45° field of view · 1932x1916px:
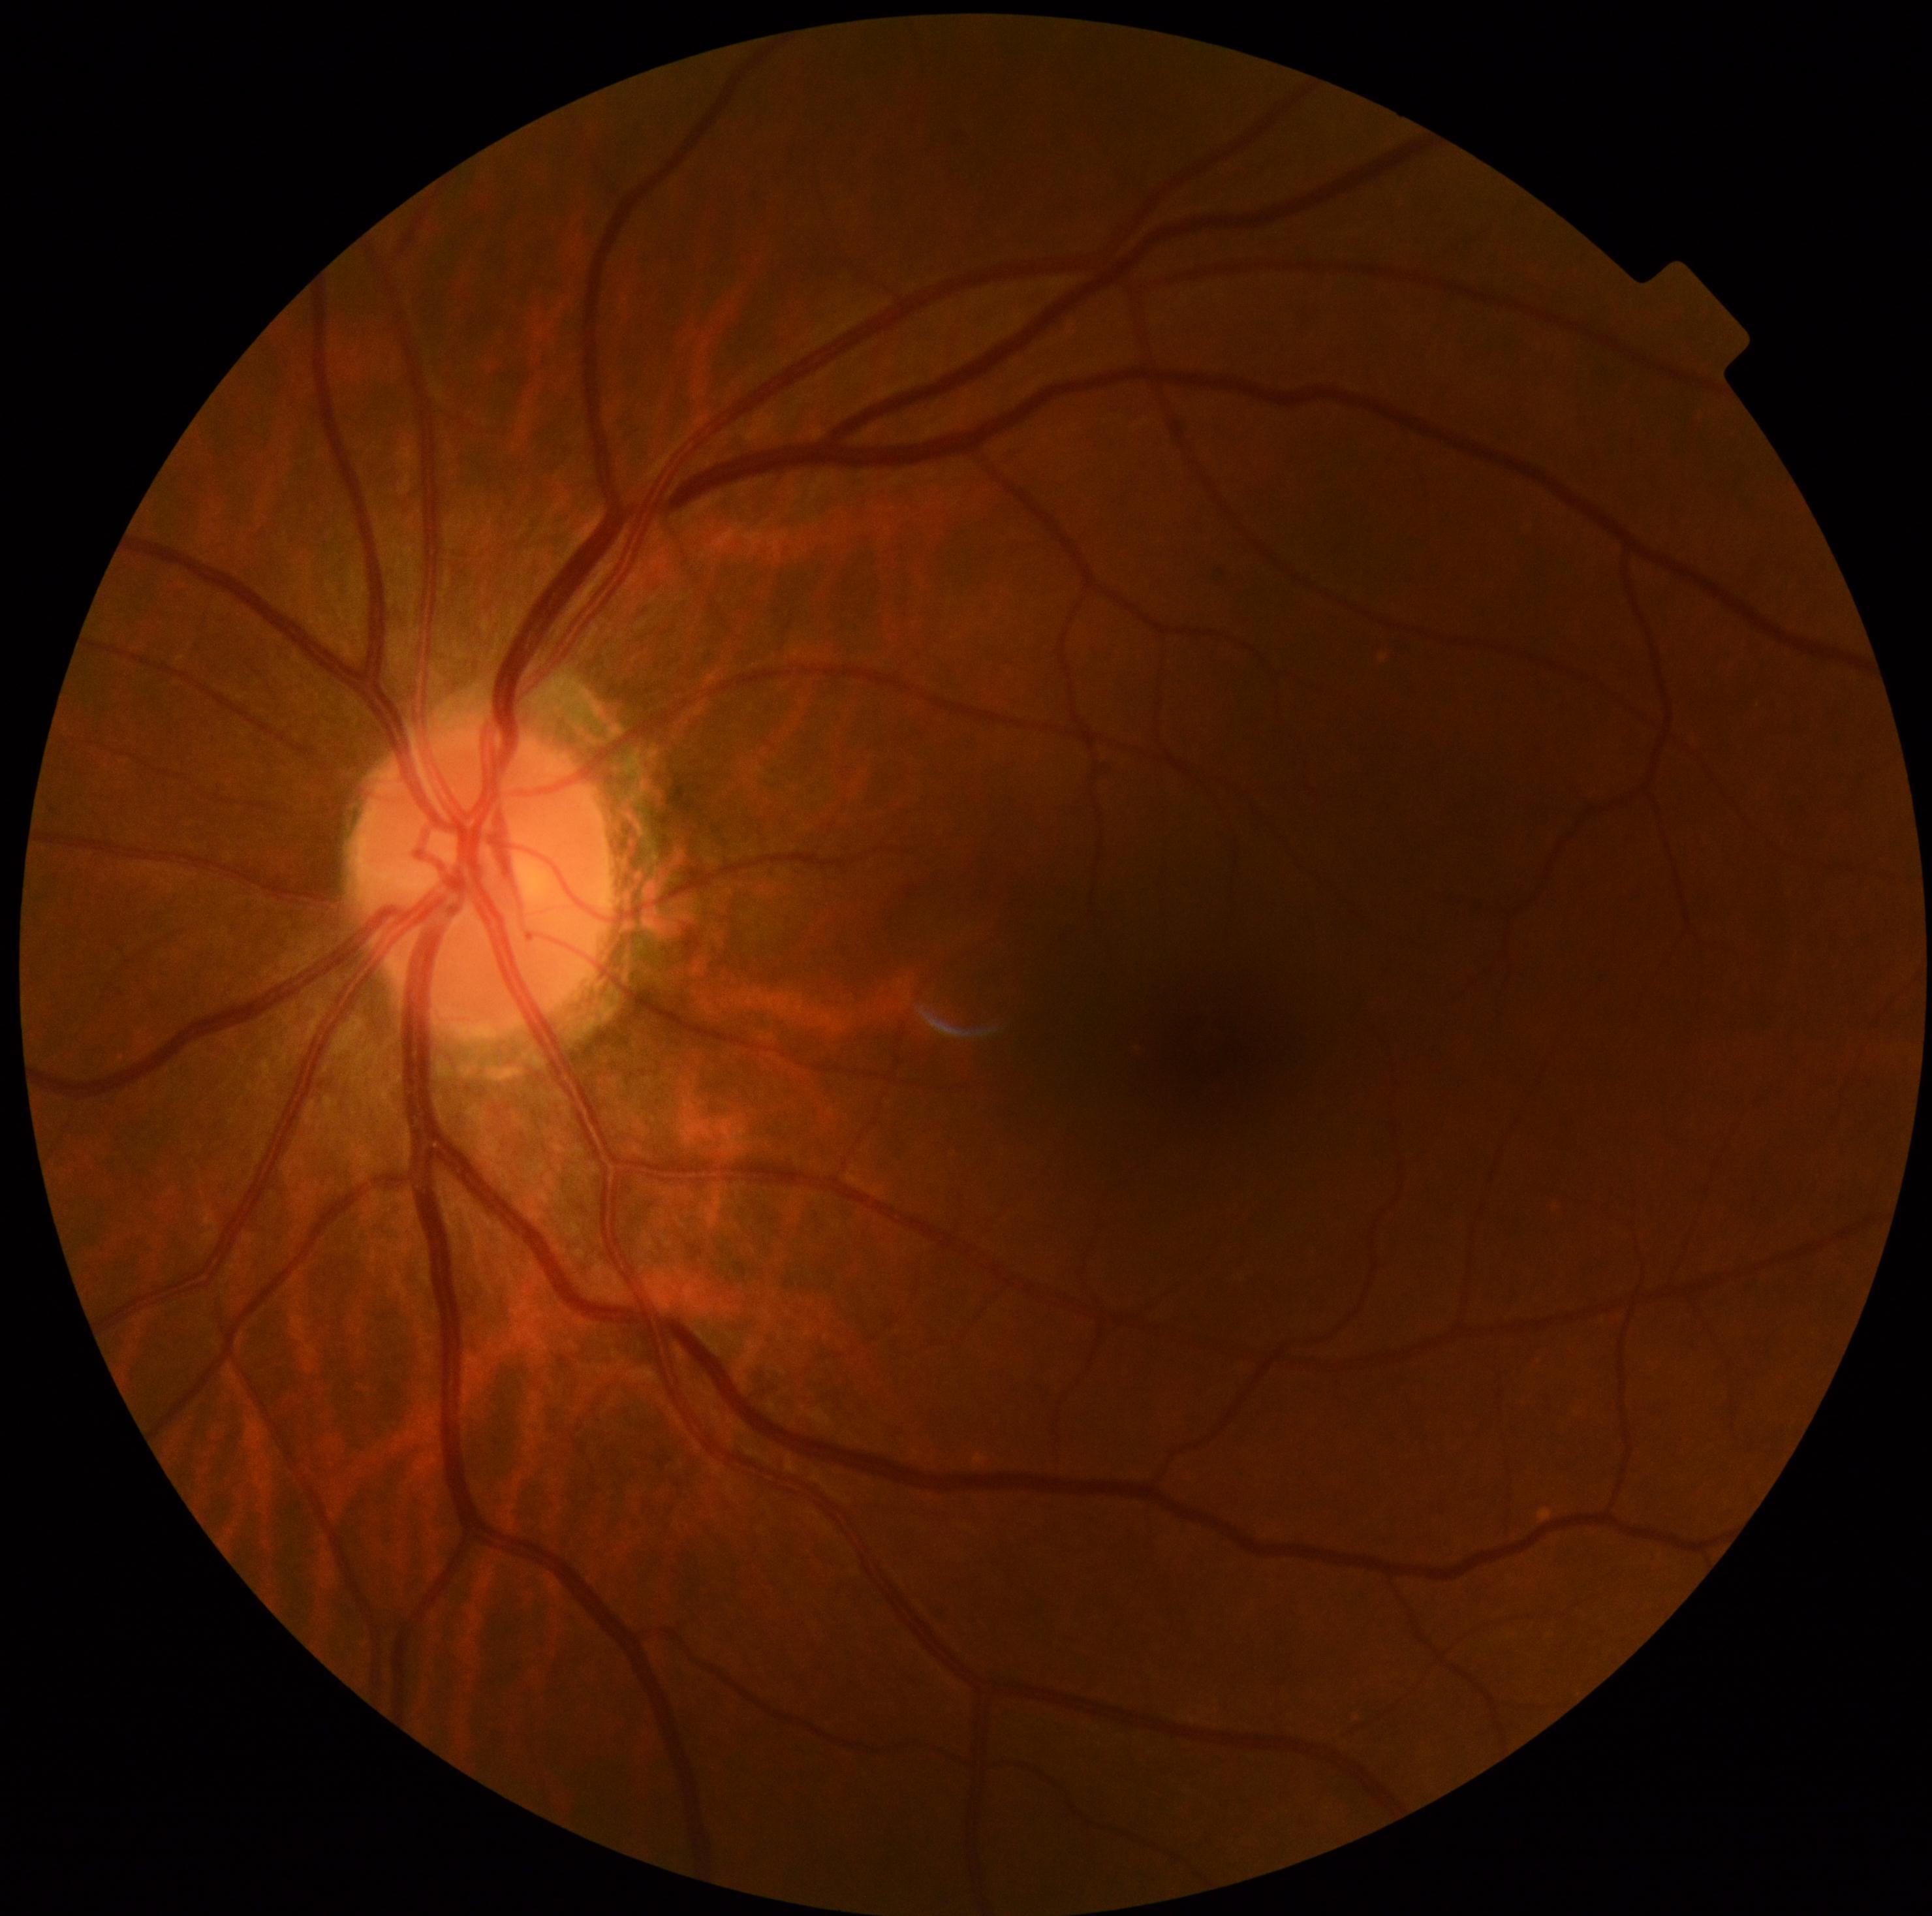
DR: grade 0 (no apparent retinopathy).